Retinal fundus photograph · 45-degree field of view · 2048 by 1536 pixels — 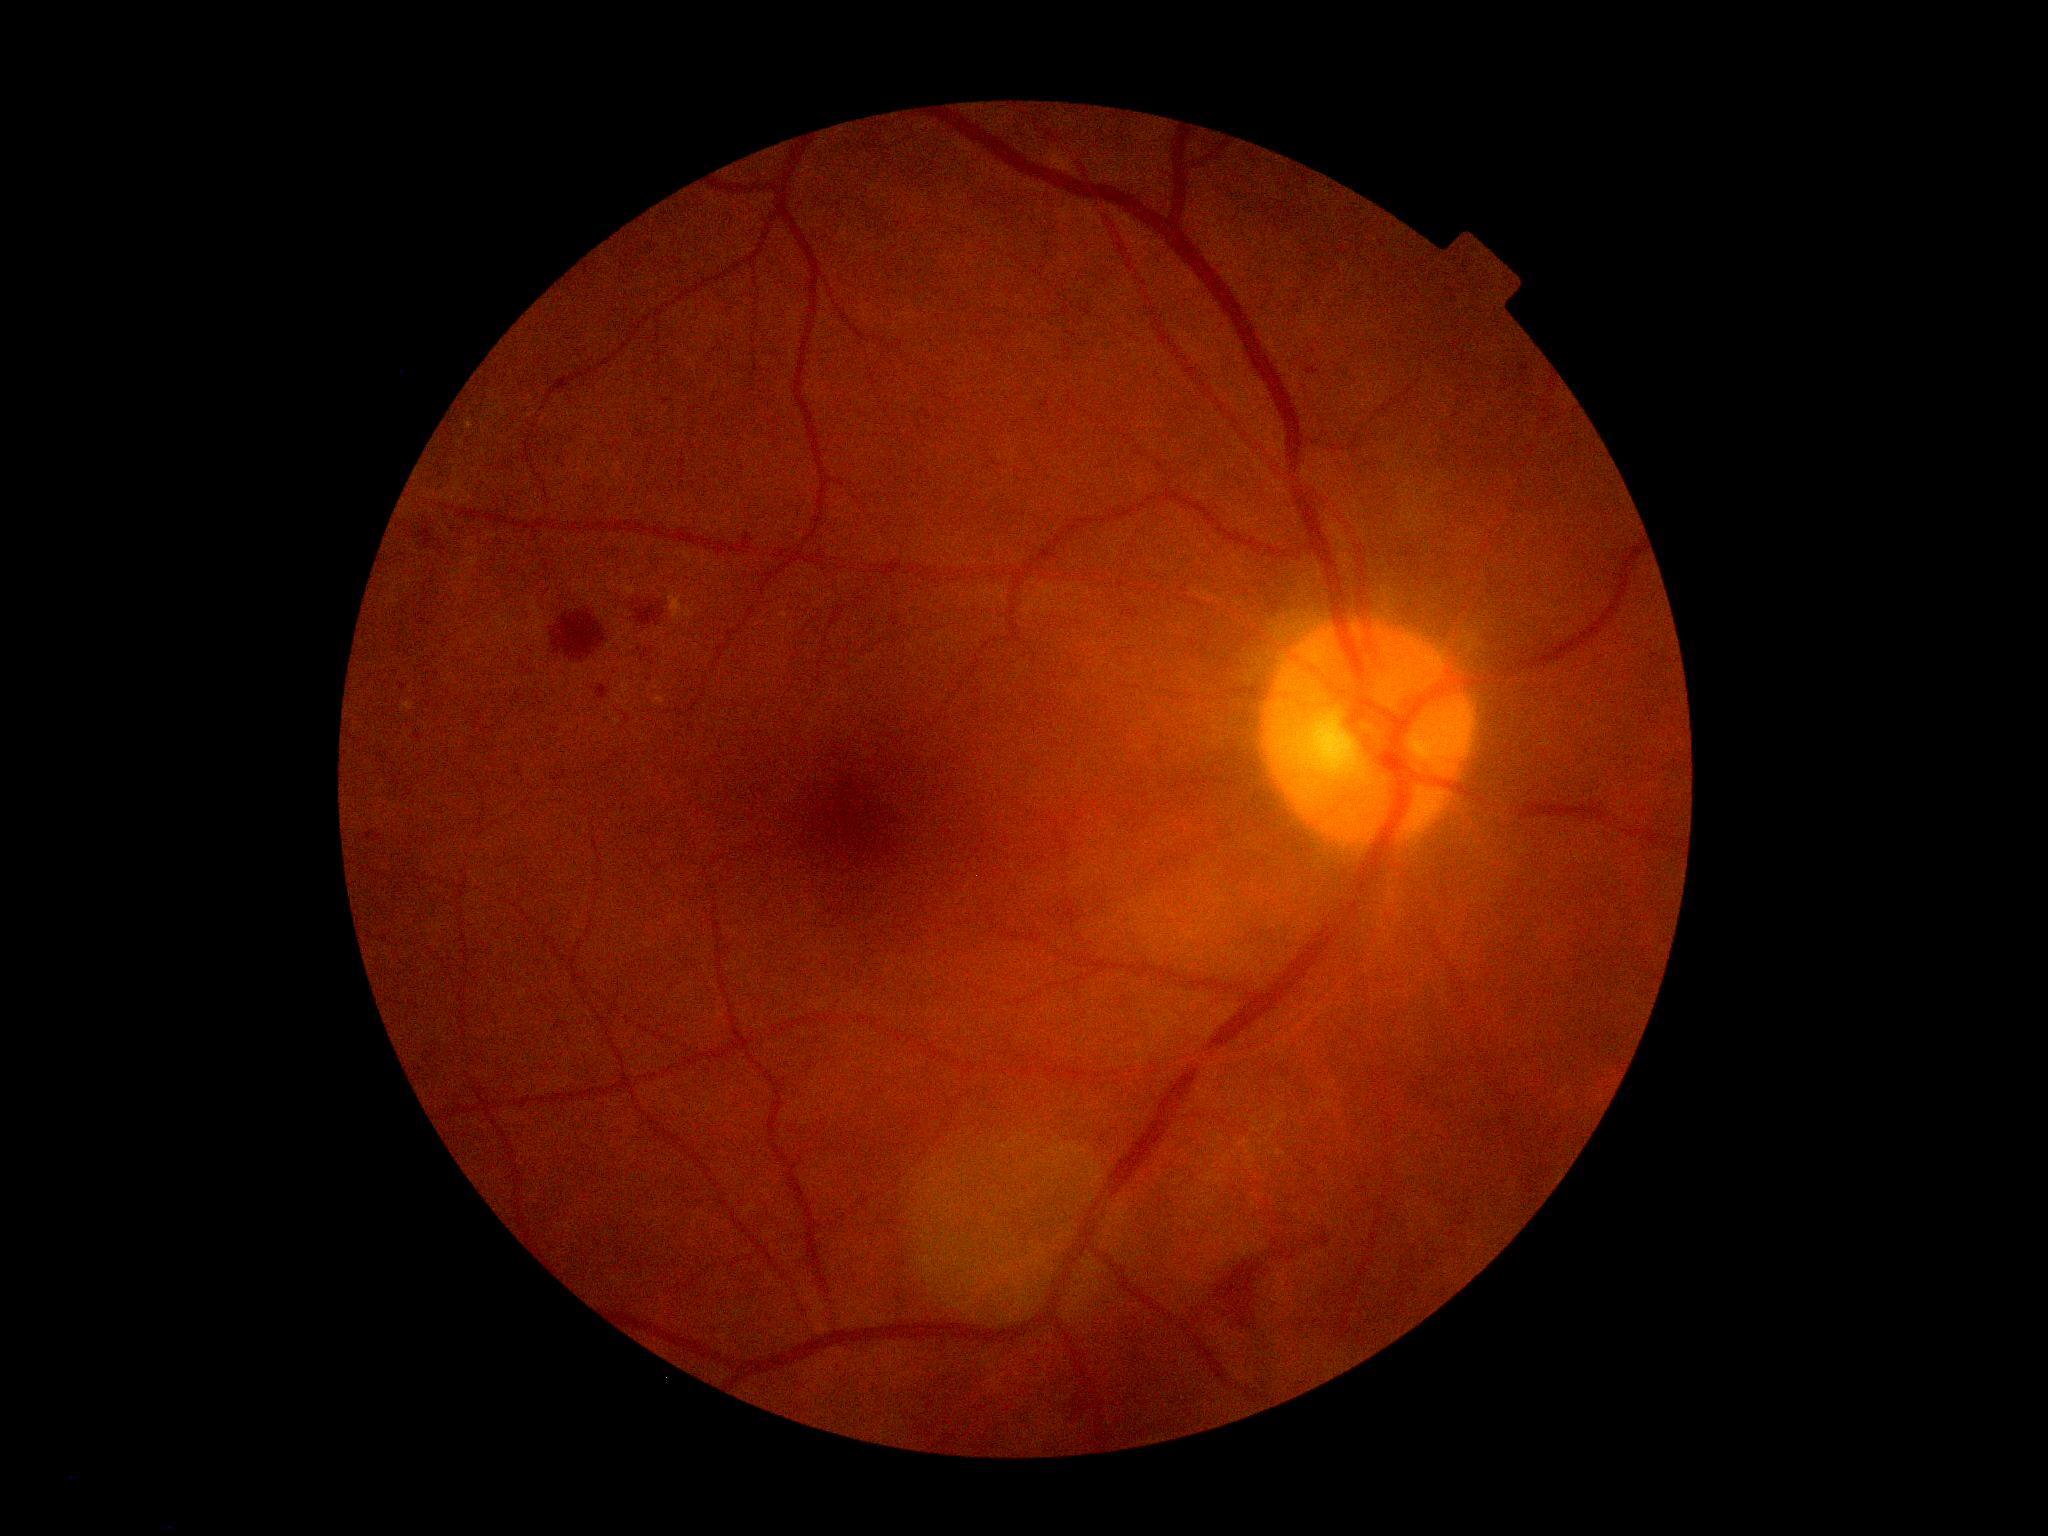
Disease class: non-proliferative diabetic retinopathy. Diabetic retinopathy (DR): grade 2 (moderate NPDR).